Camera: Topcon TRC-50DX · field includes the optic disc and macula · 2228x1652: 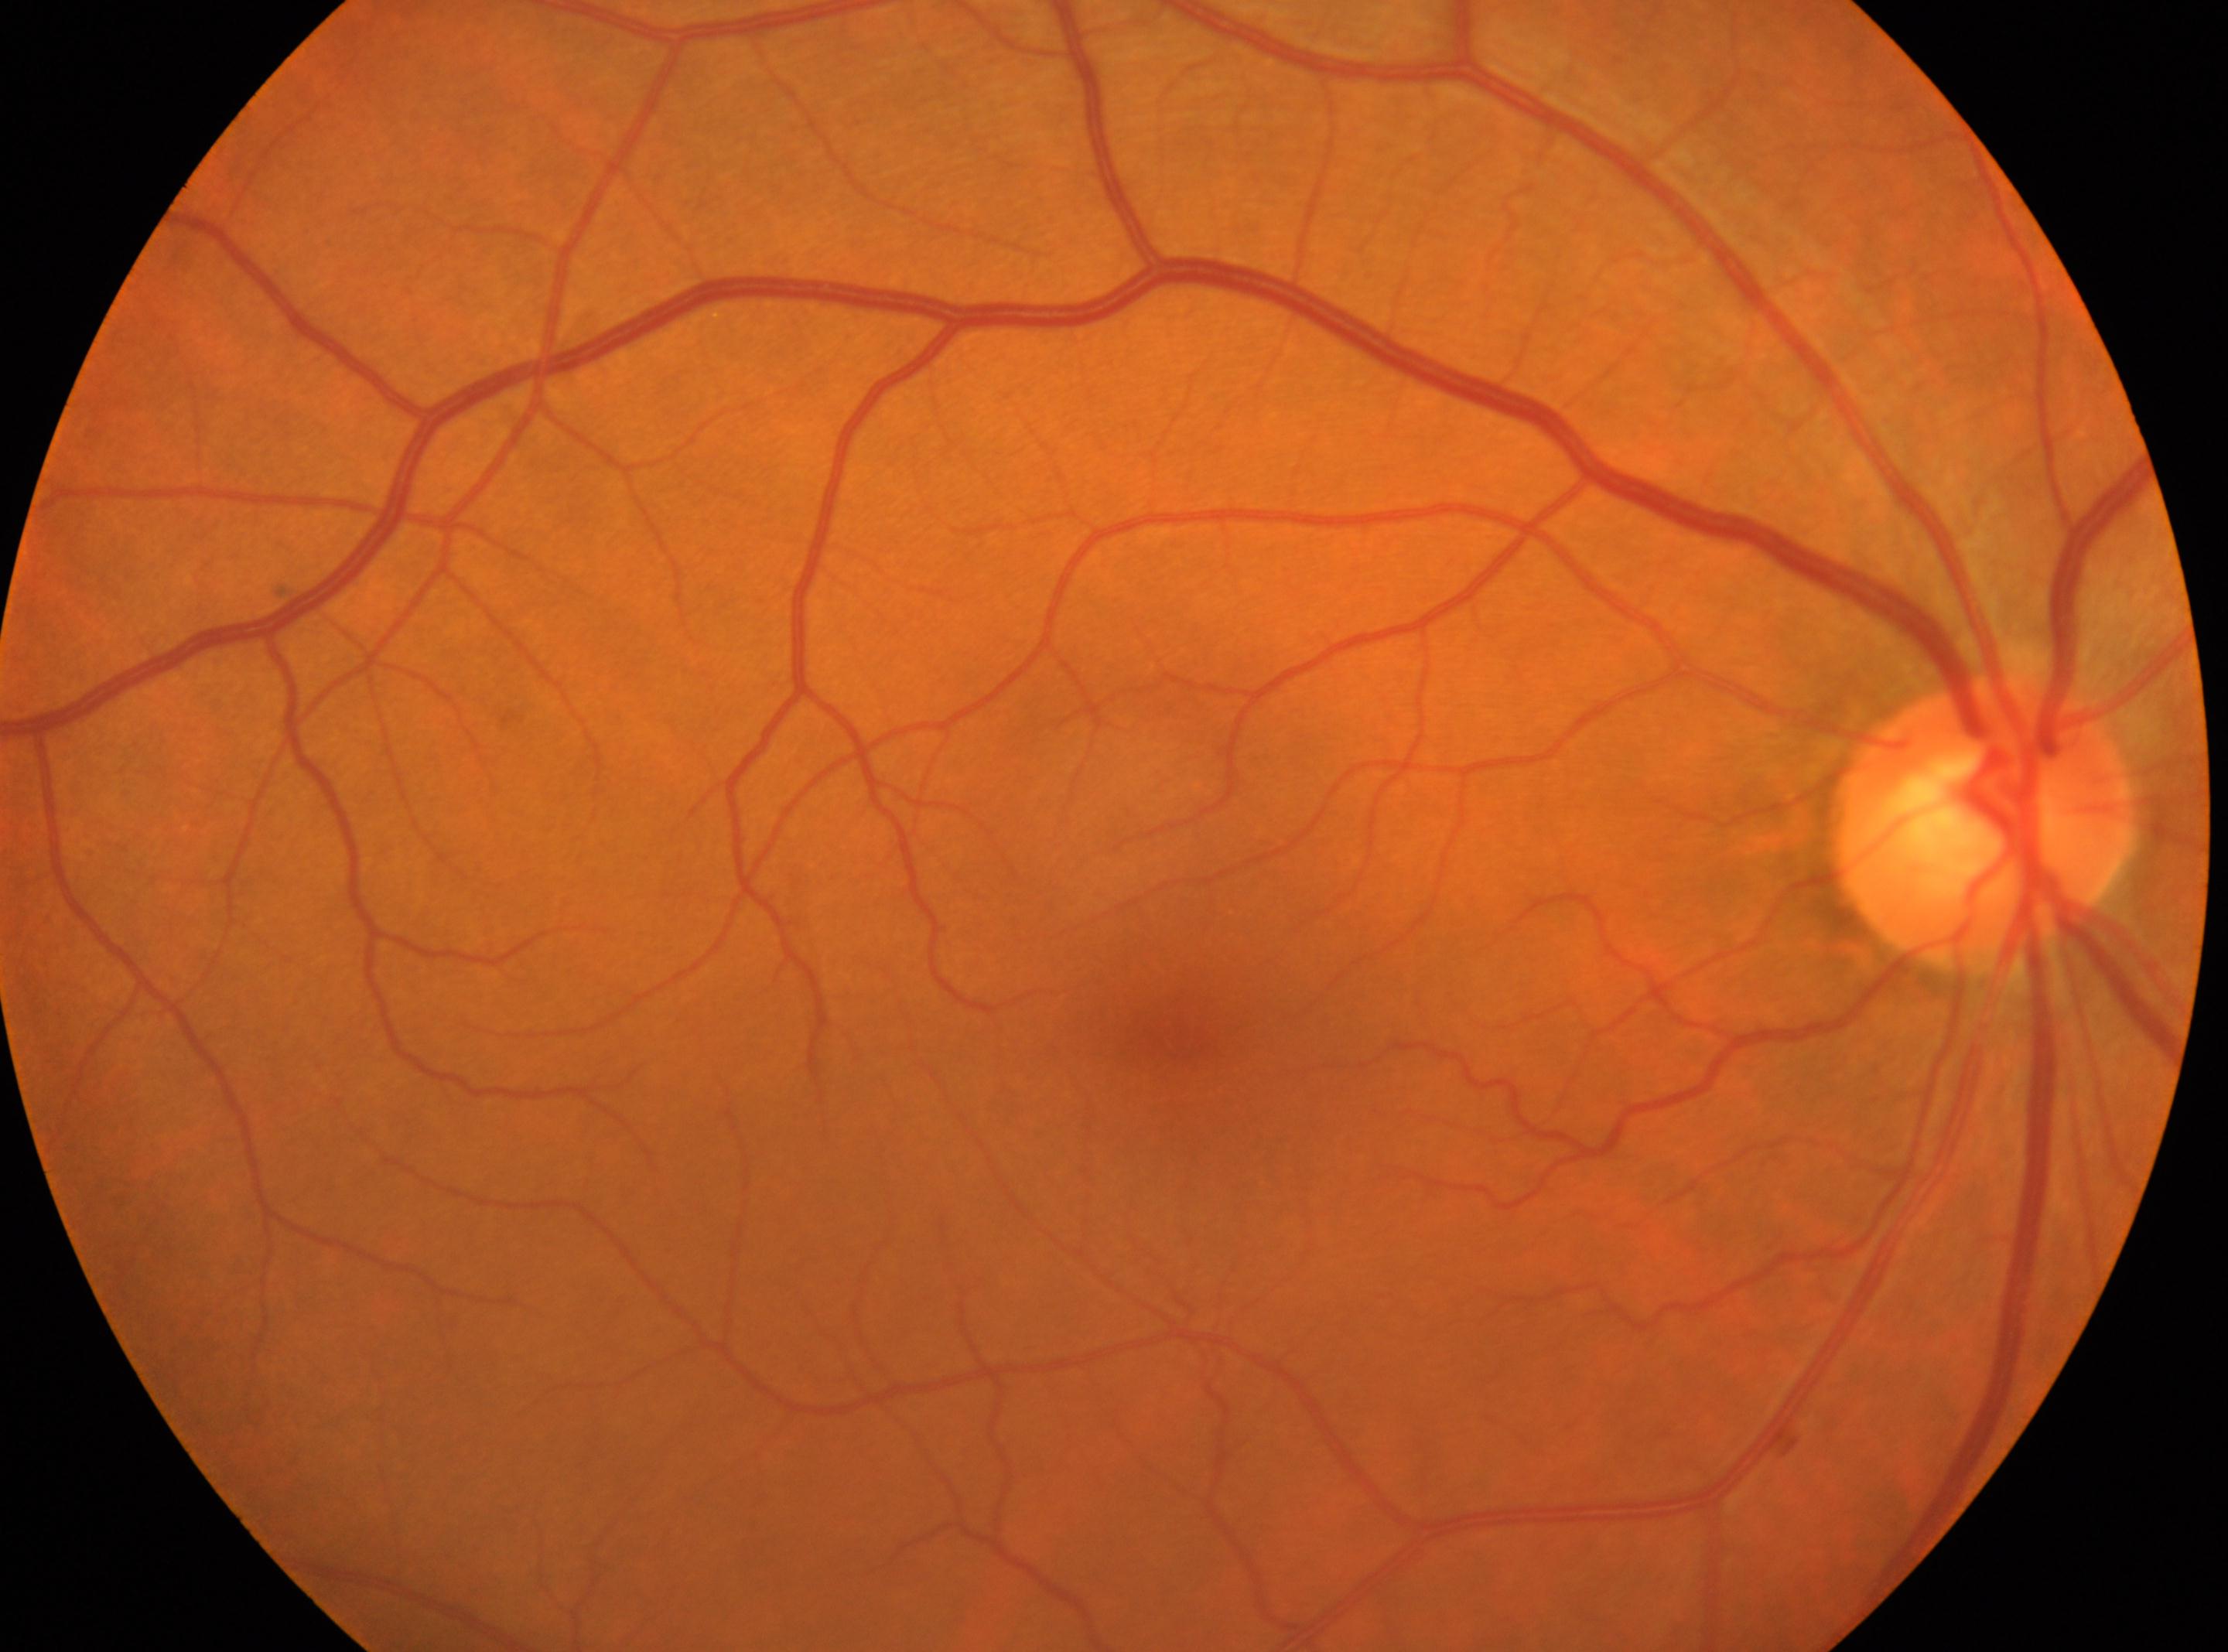
Q: Where is the fovea?
A: 1177px, 1038px
Q: Optic disc center?
A: 1983px, 820px
Q: Diabetic retinopathy severity?
A: 0/4
Q: Which eye is imaged?
A: oculus dexter